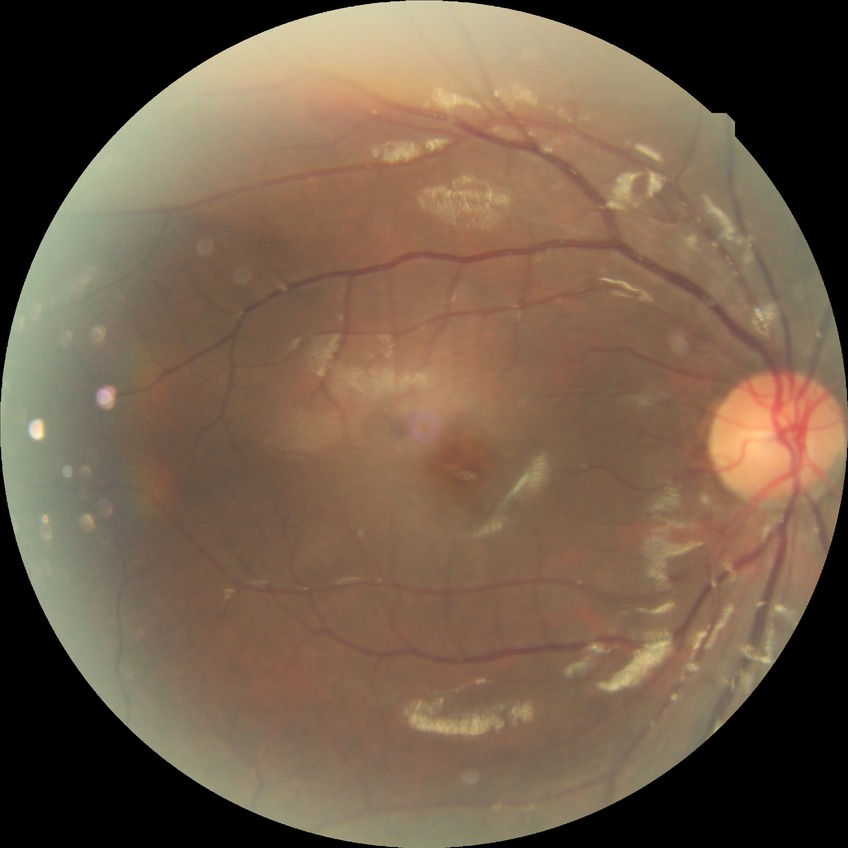
Diabetic retinopathy (DR) is SDR (simple diabetic retinopathy).